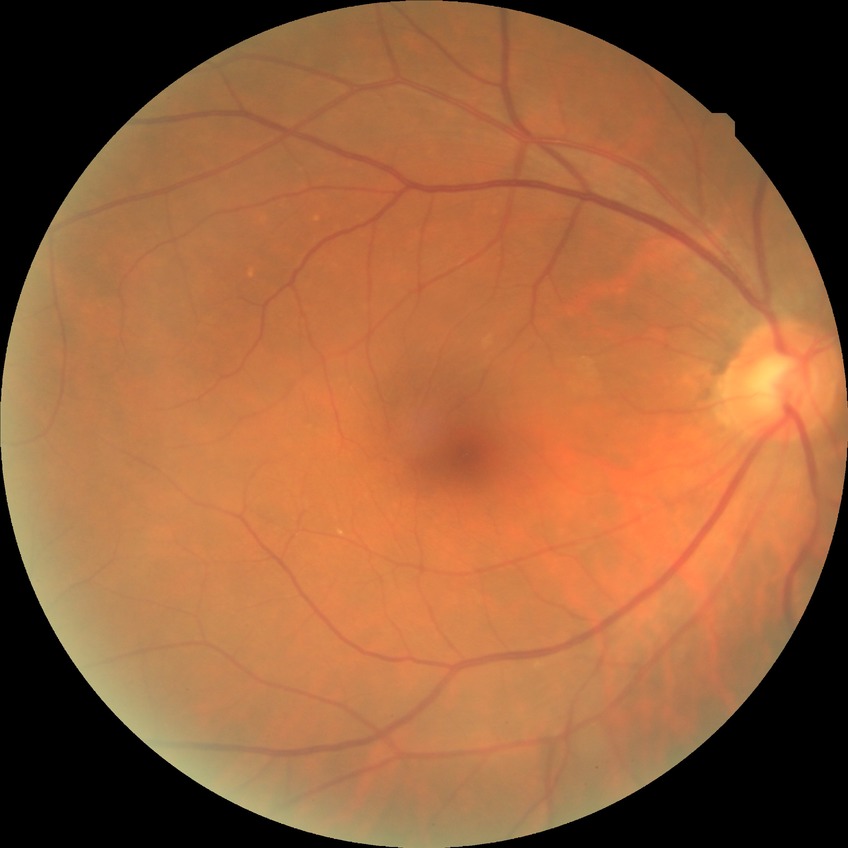 diabetic retinopathy (DR): NDR (no diabetic retinopathy)